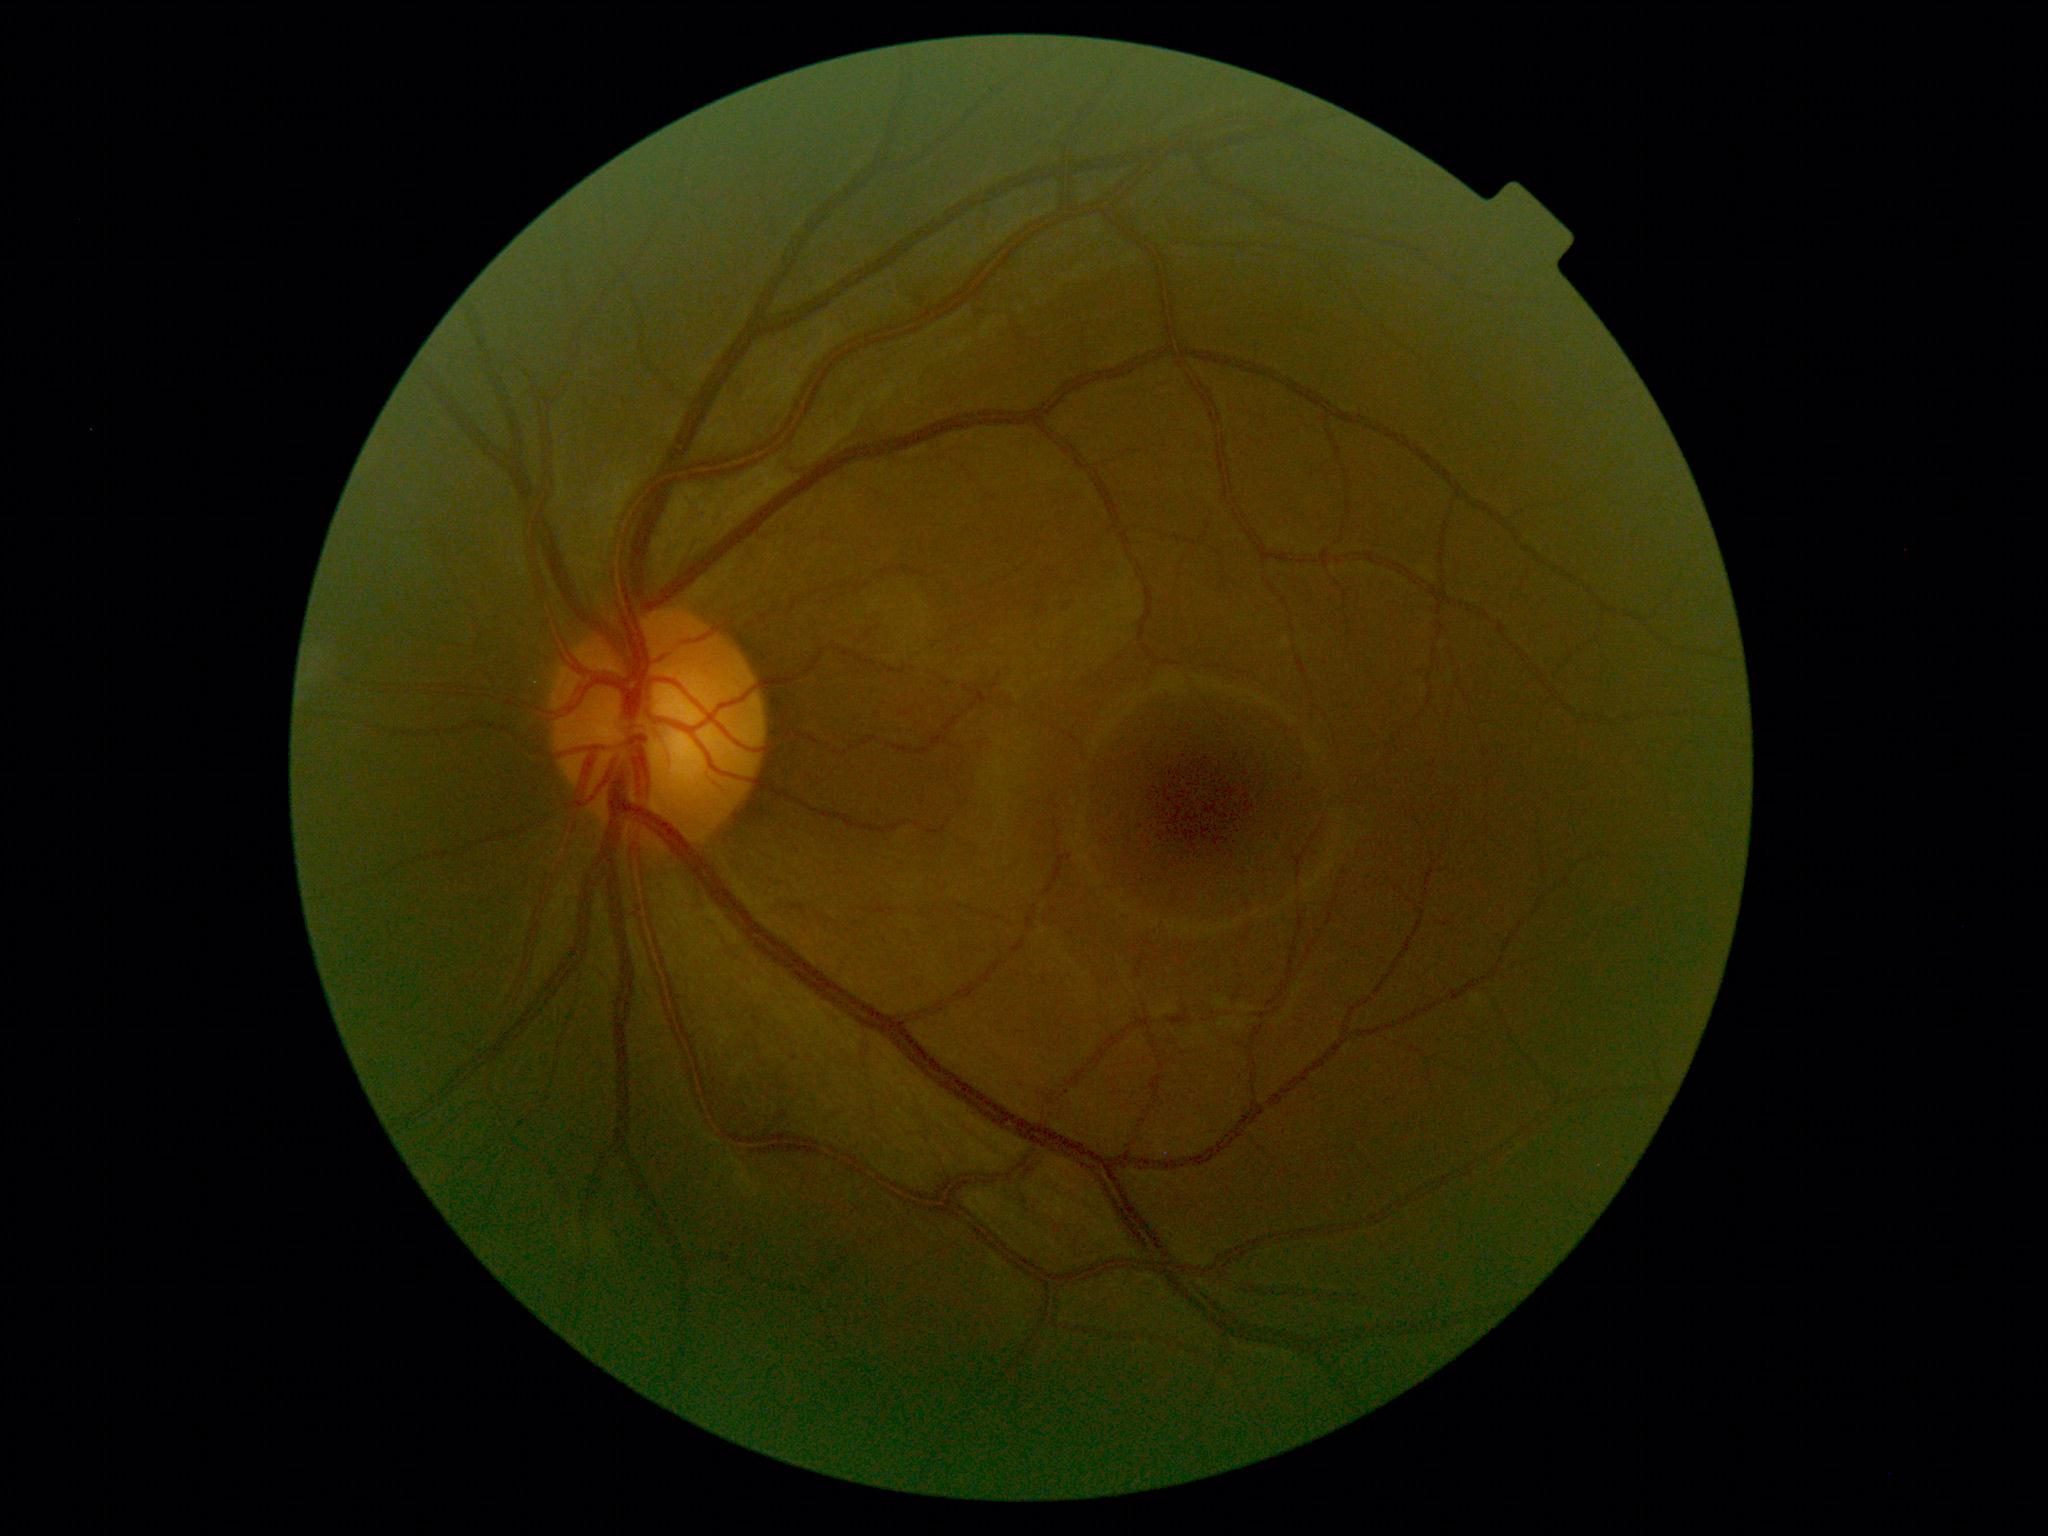

DR impression: negative for DR; DR: 0/4.